Optic disc at the center of the field; axial length: 24.37 mm; 2212x1661px; man patient; FOV: 30 degrees; acquired with a Topcon TRC-NW400: 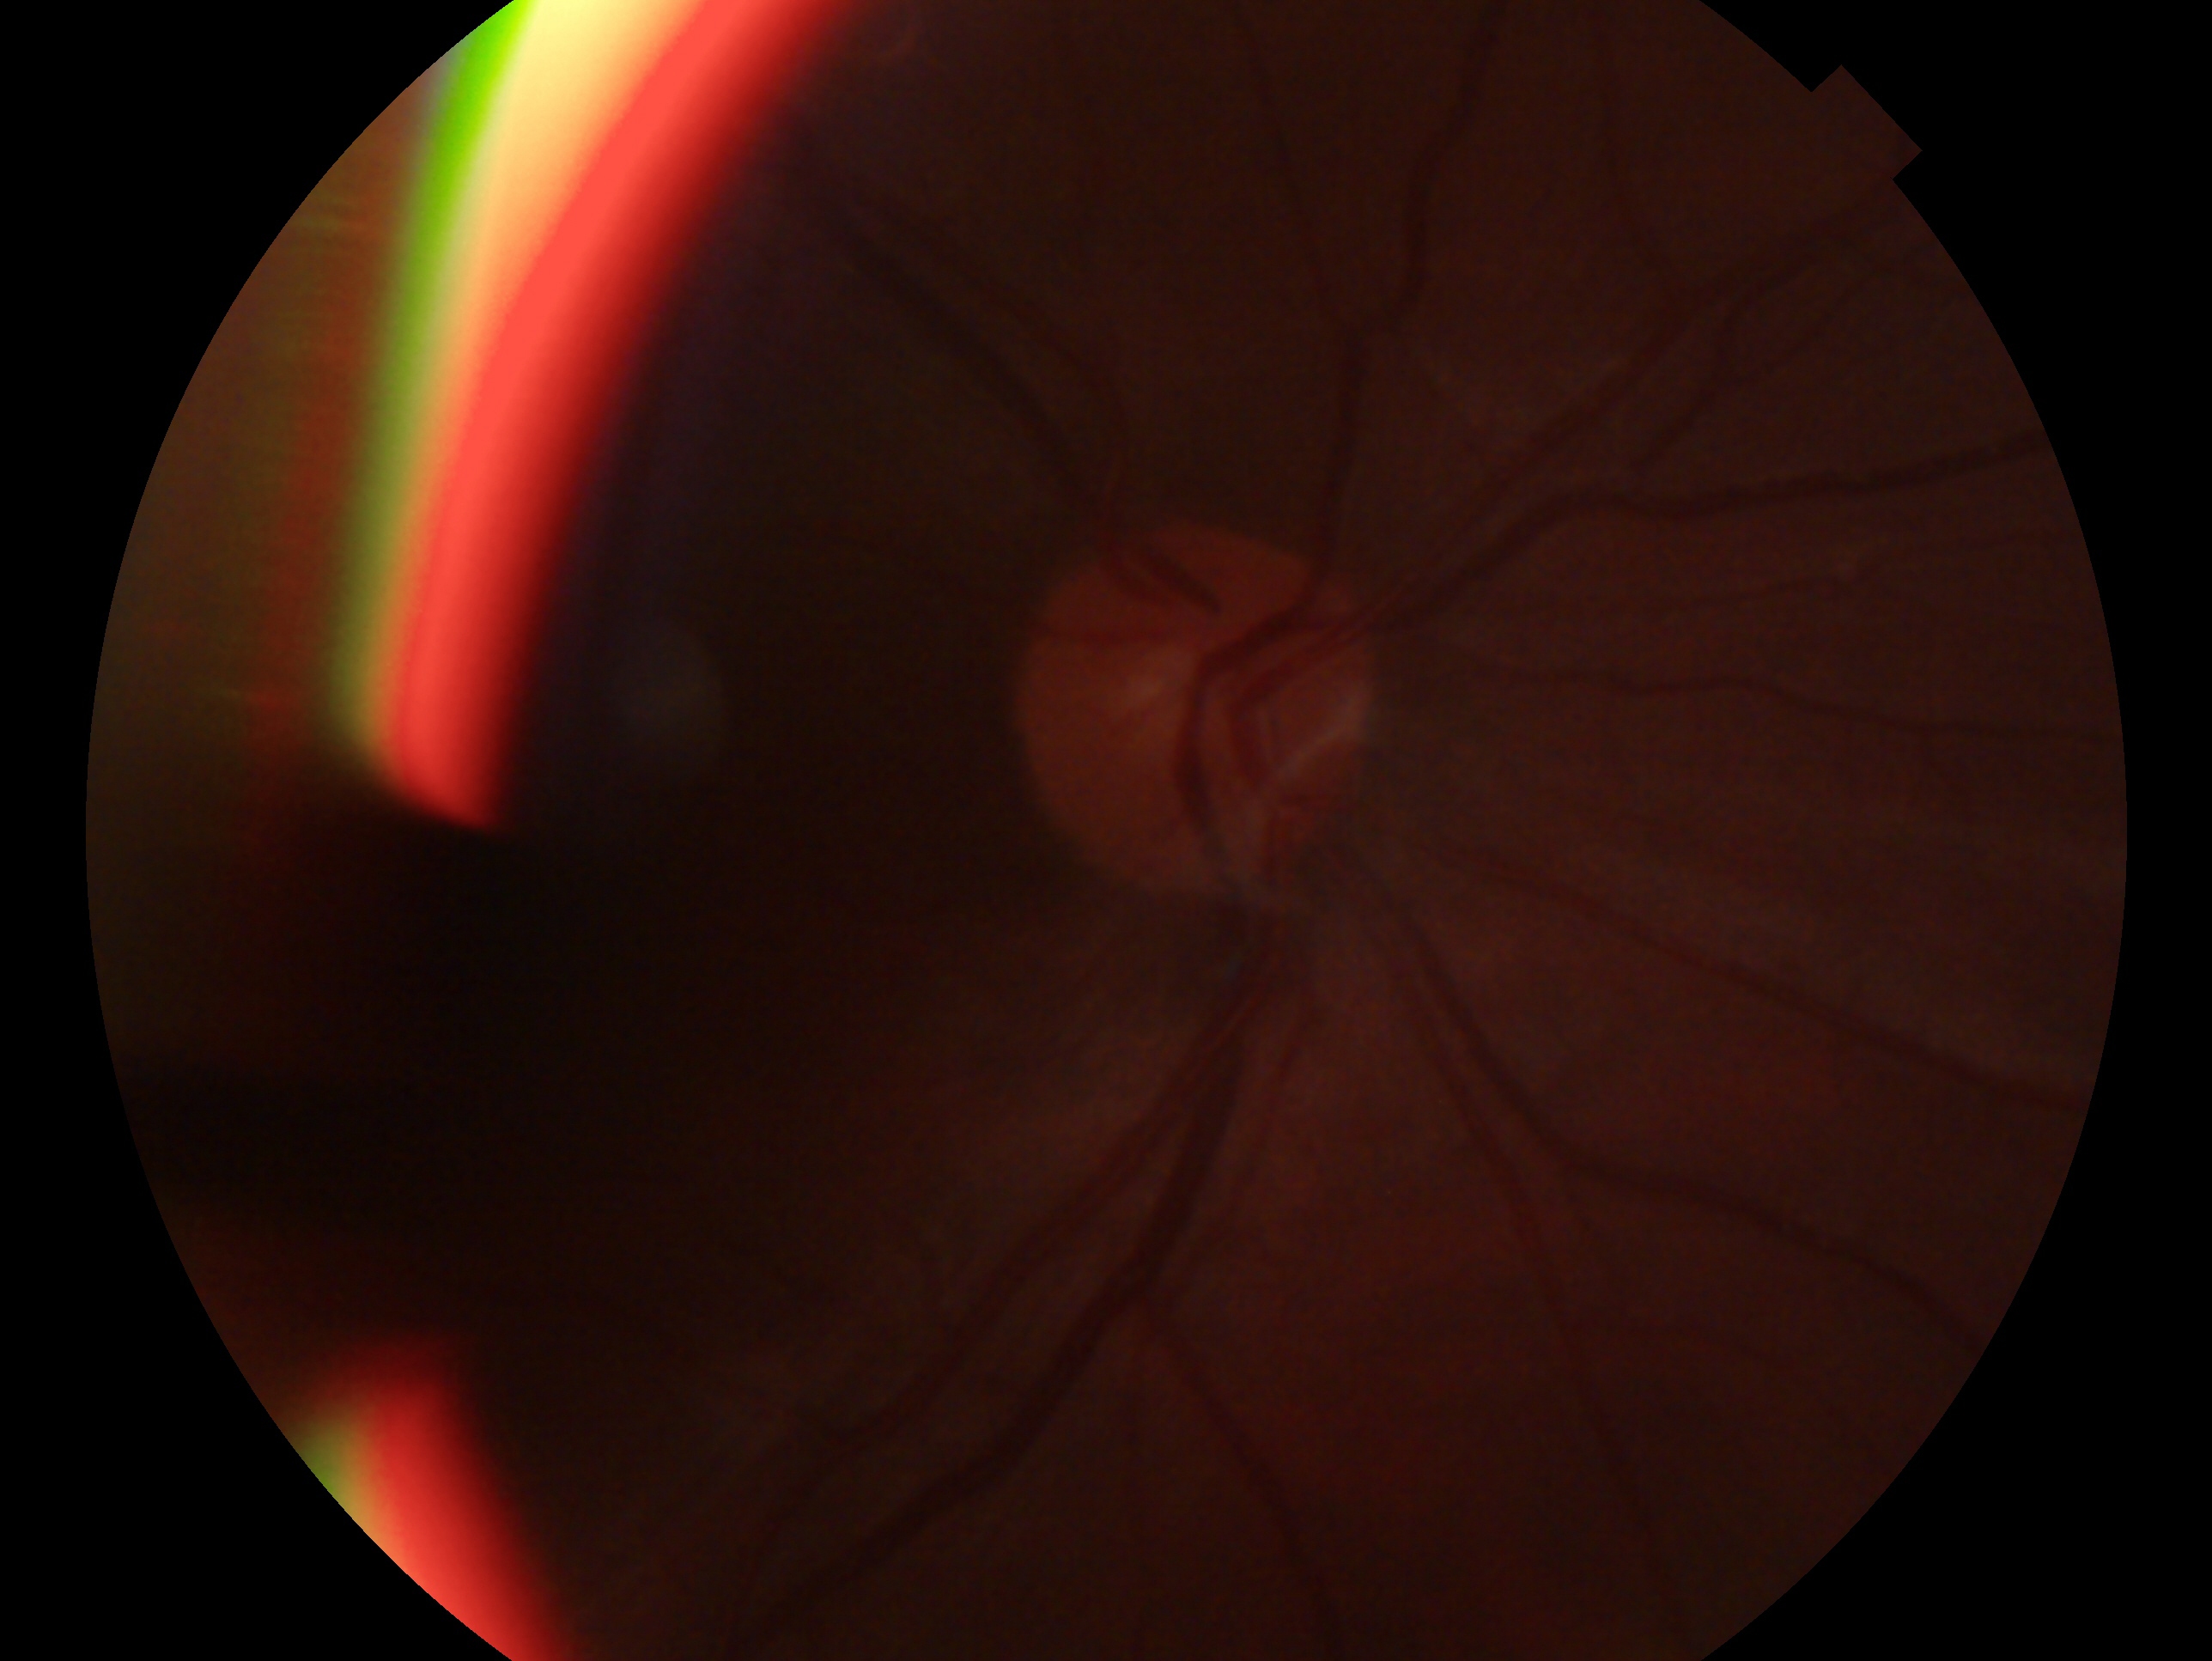 Imaged eye: OD.
Assessment: negative for glaucoma — no clinical evidence of glaucoma in this eye.